NIDEK AFC-230 fundus camera:
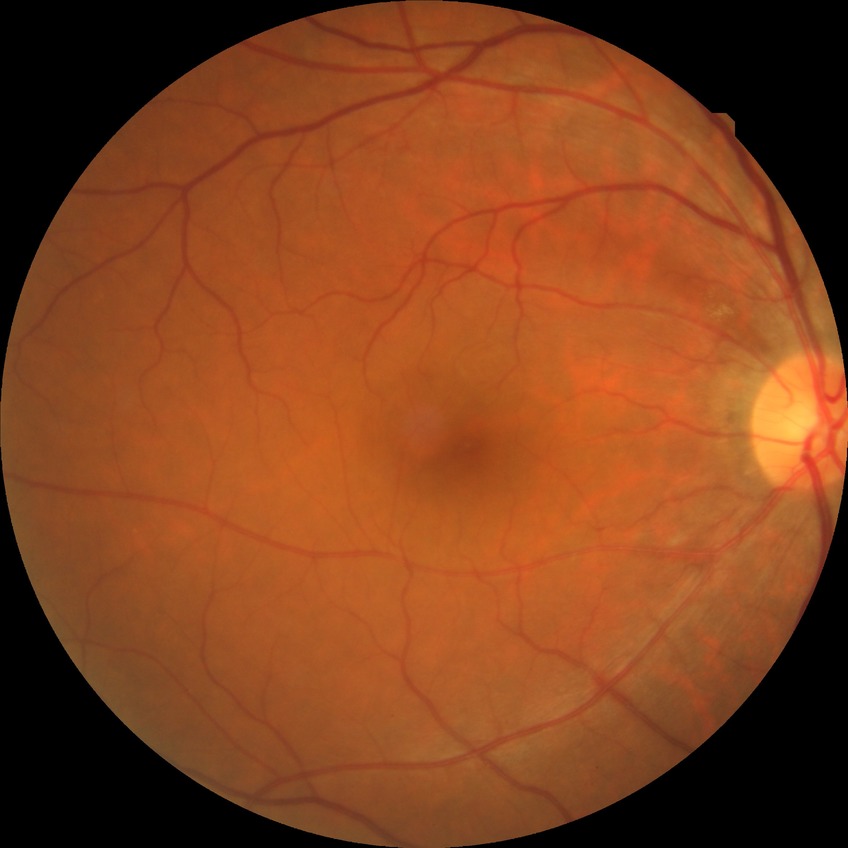
DR: NDR.